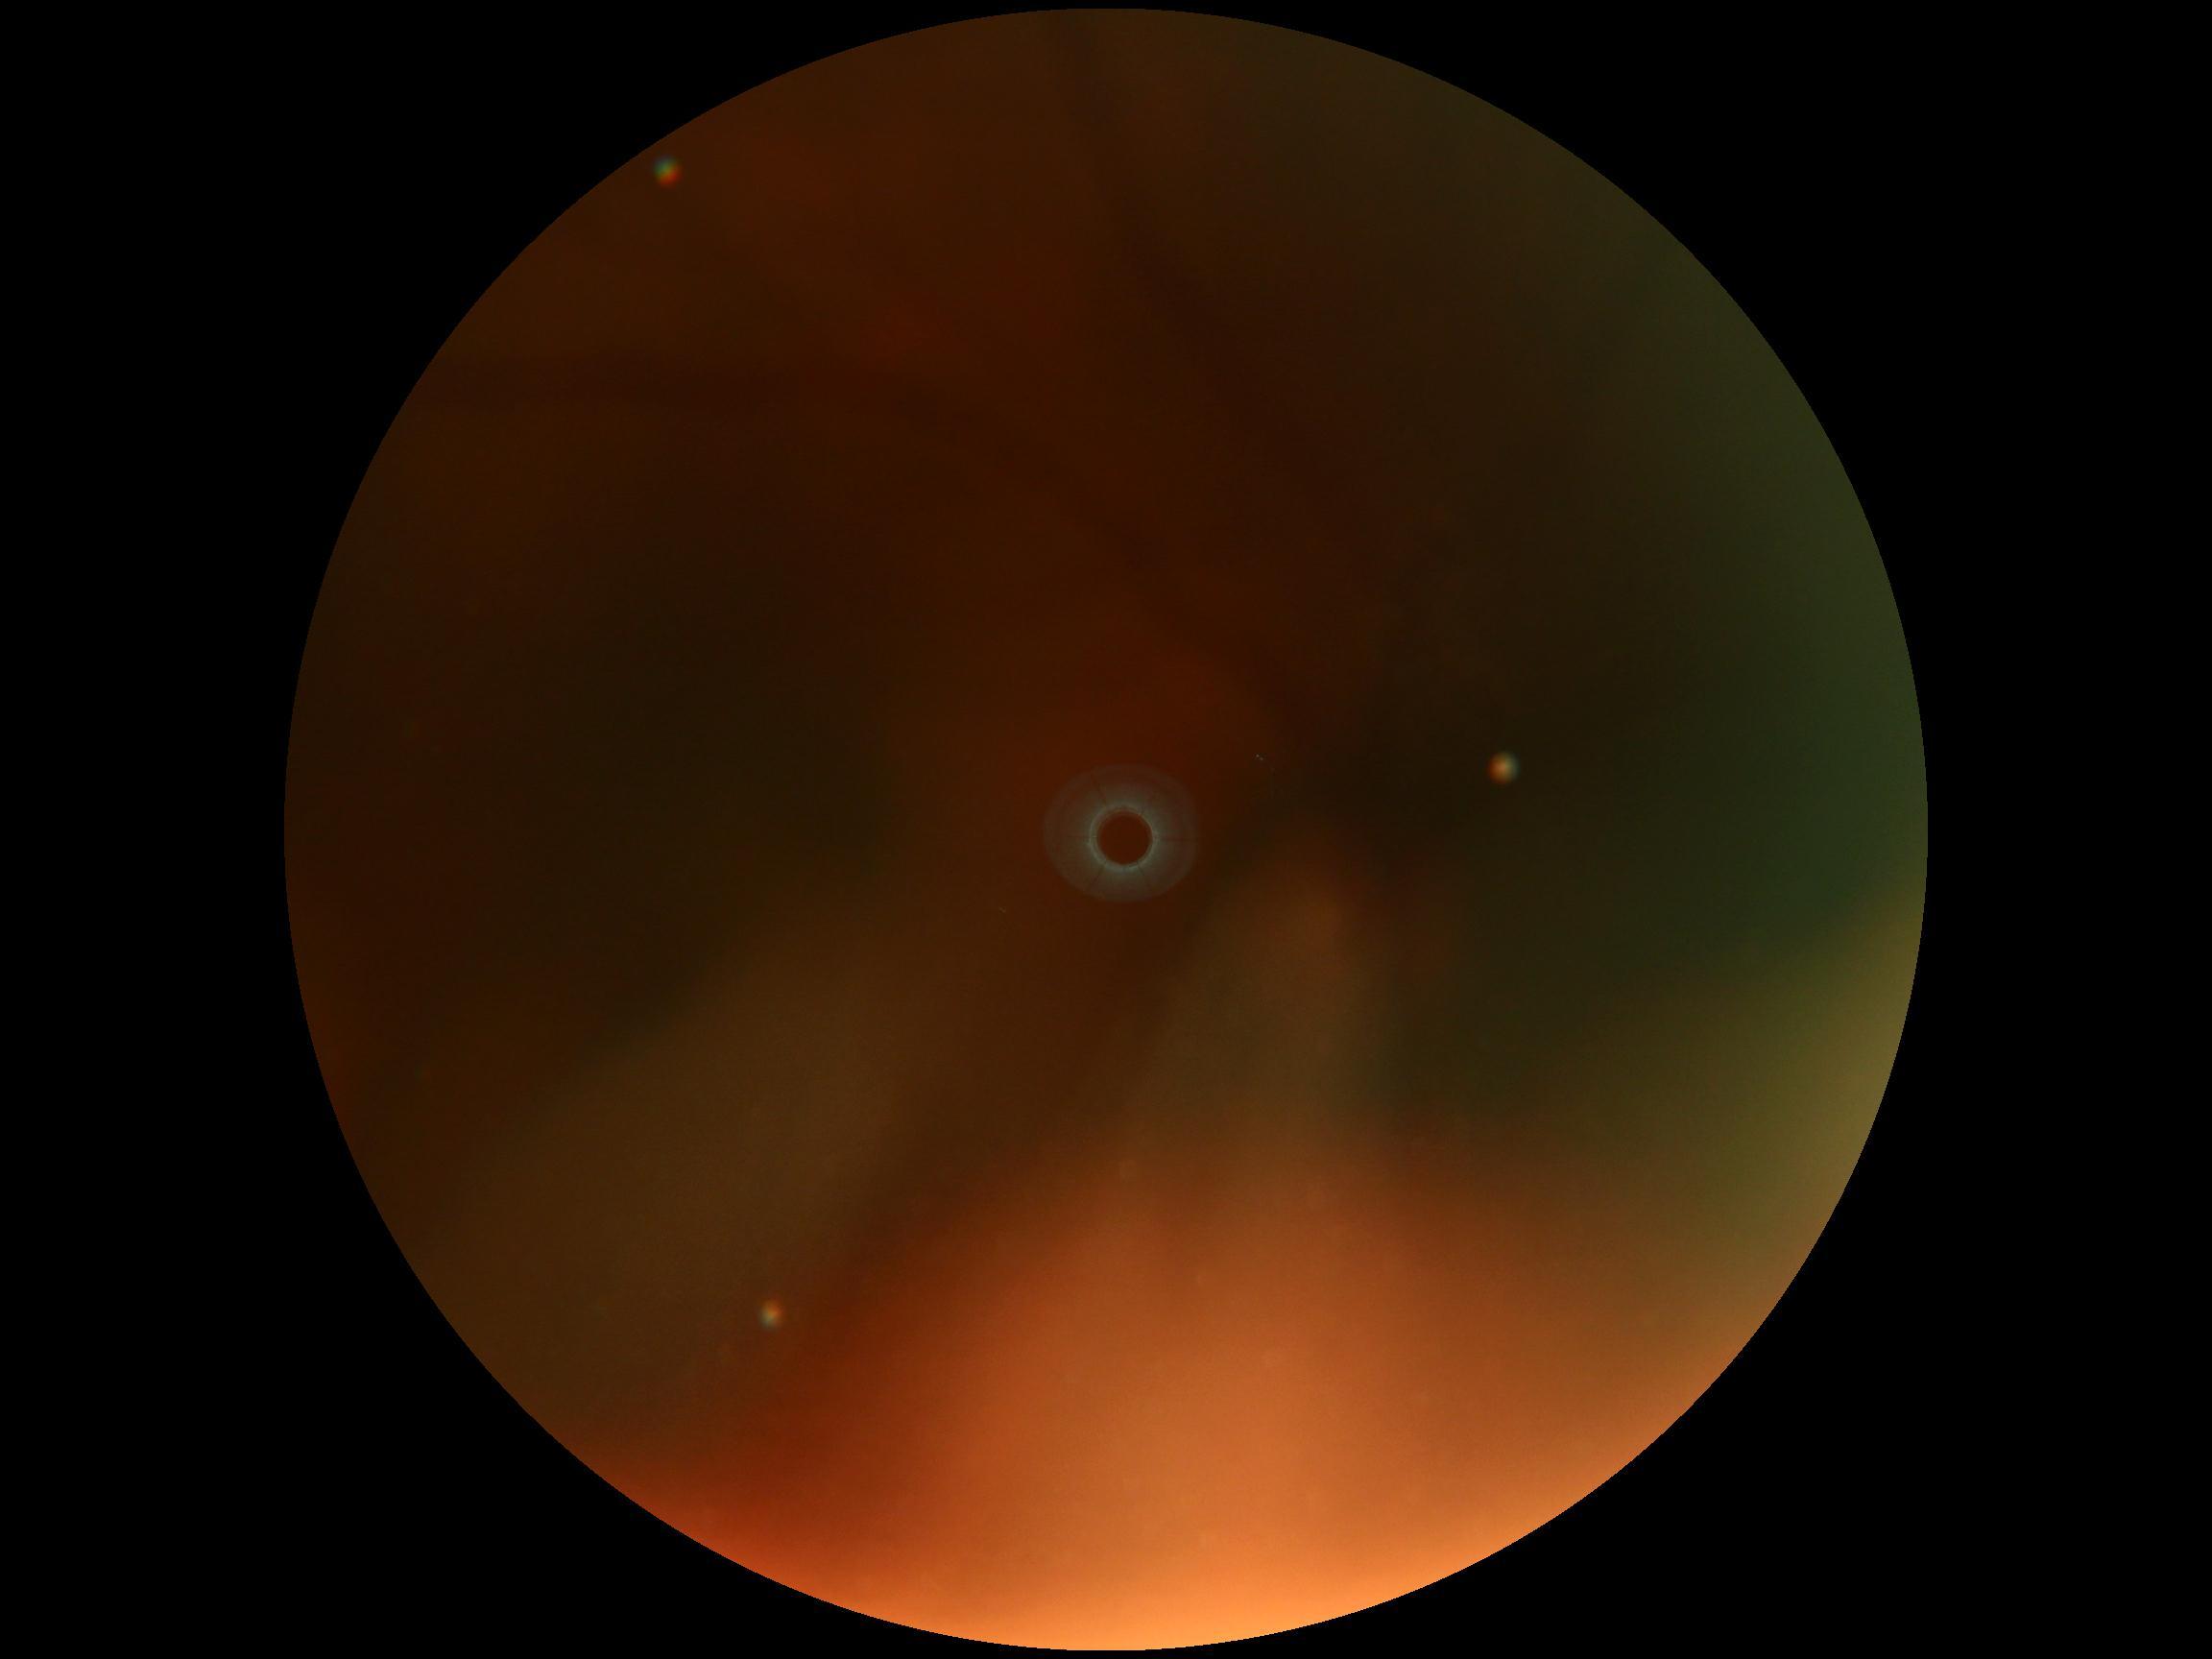 Diabetic retinopathy: ungradable.